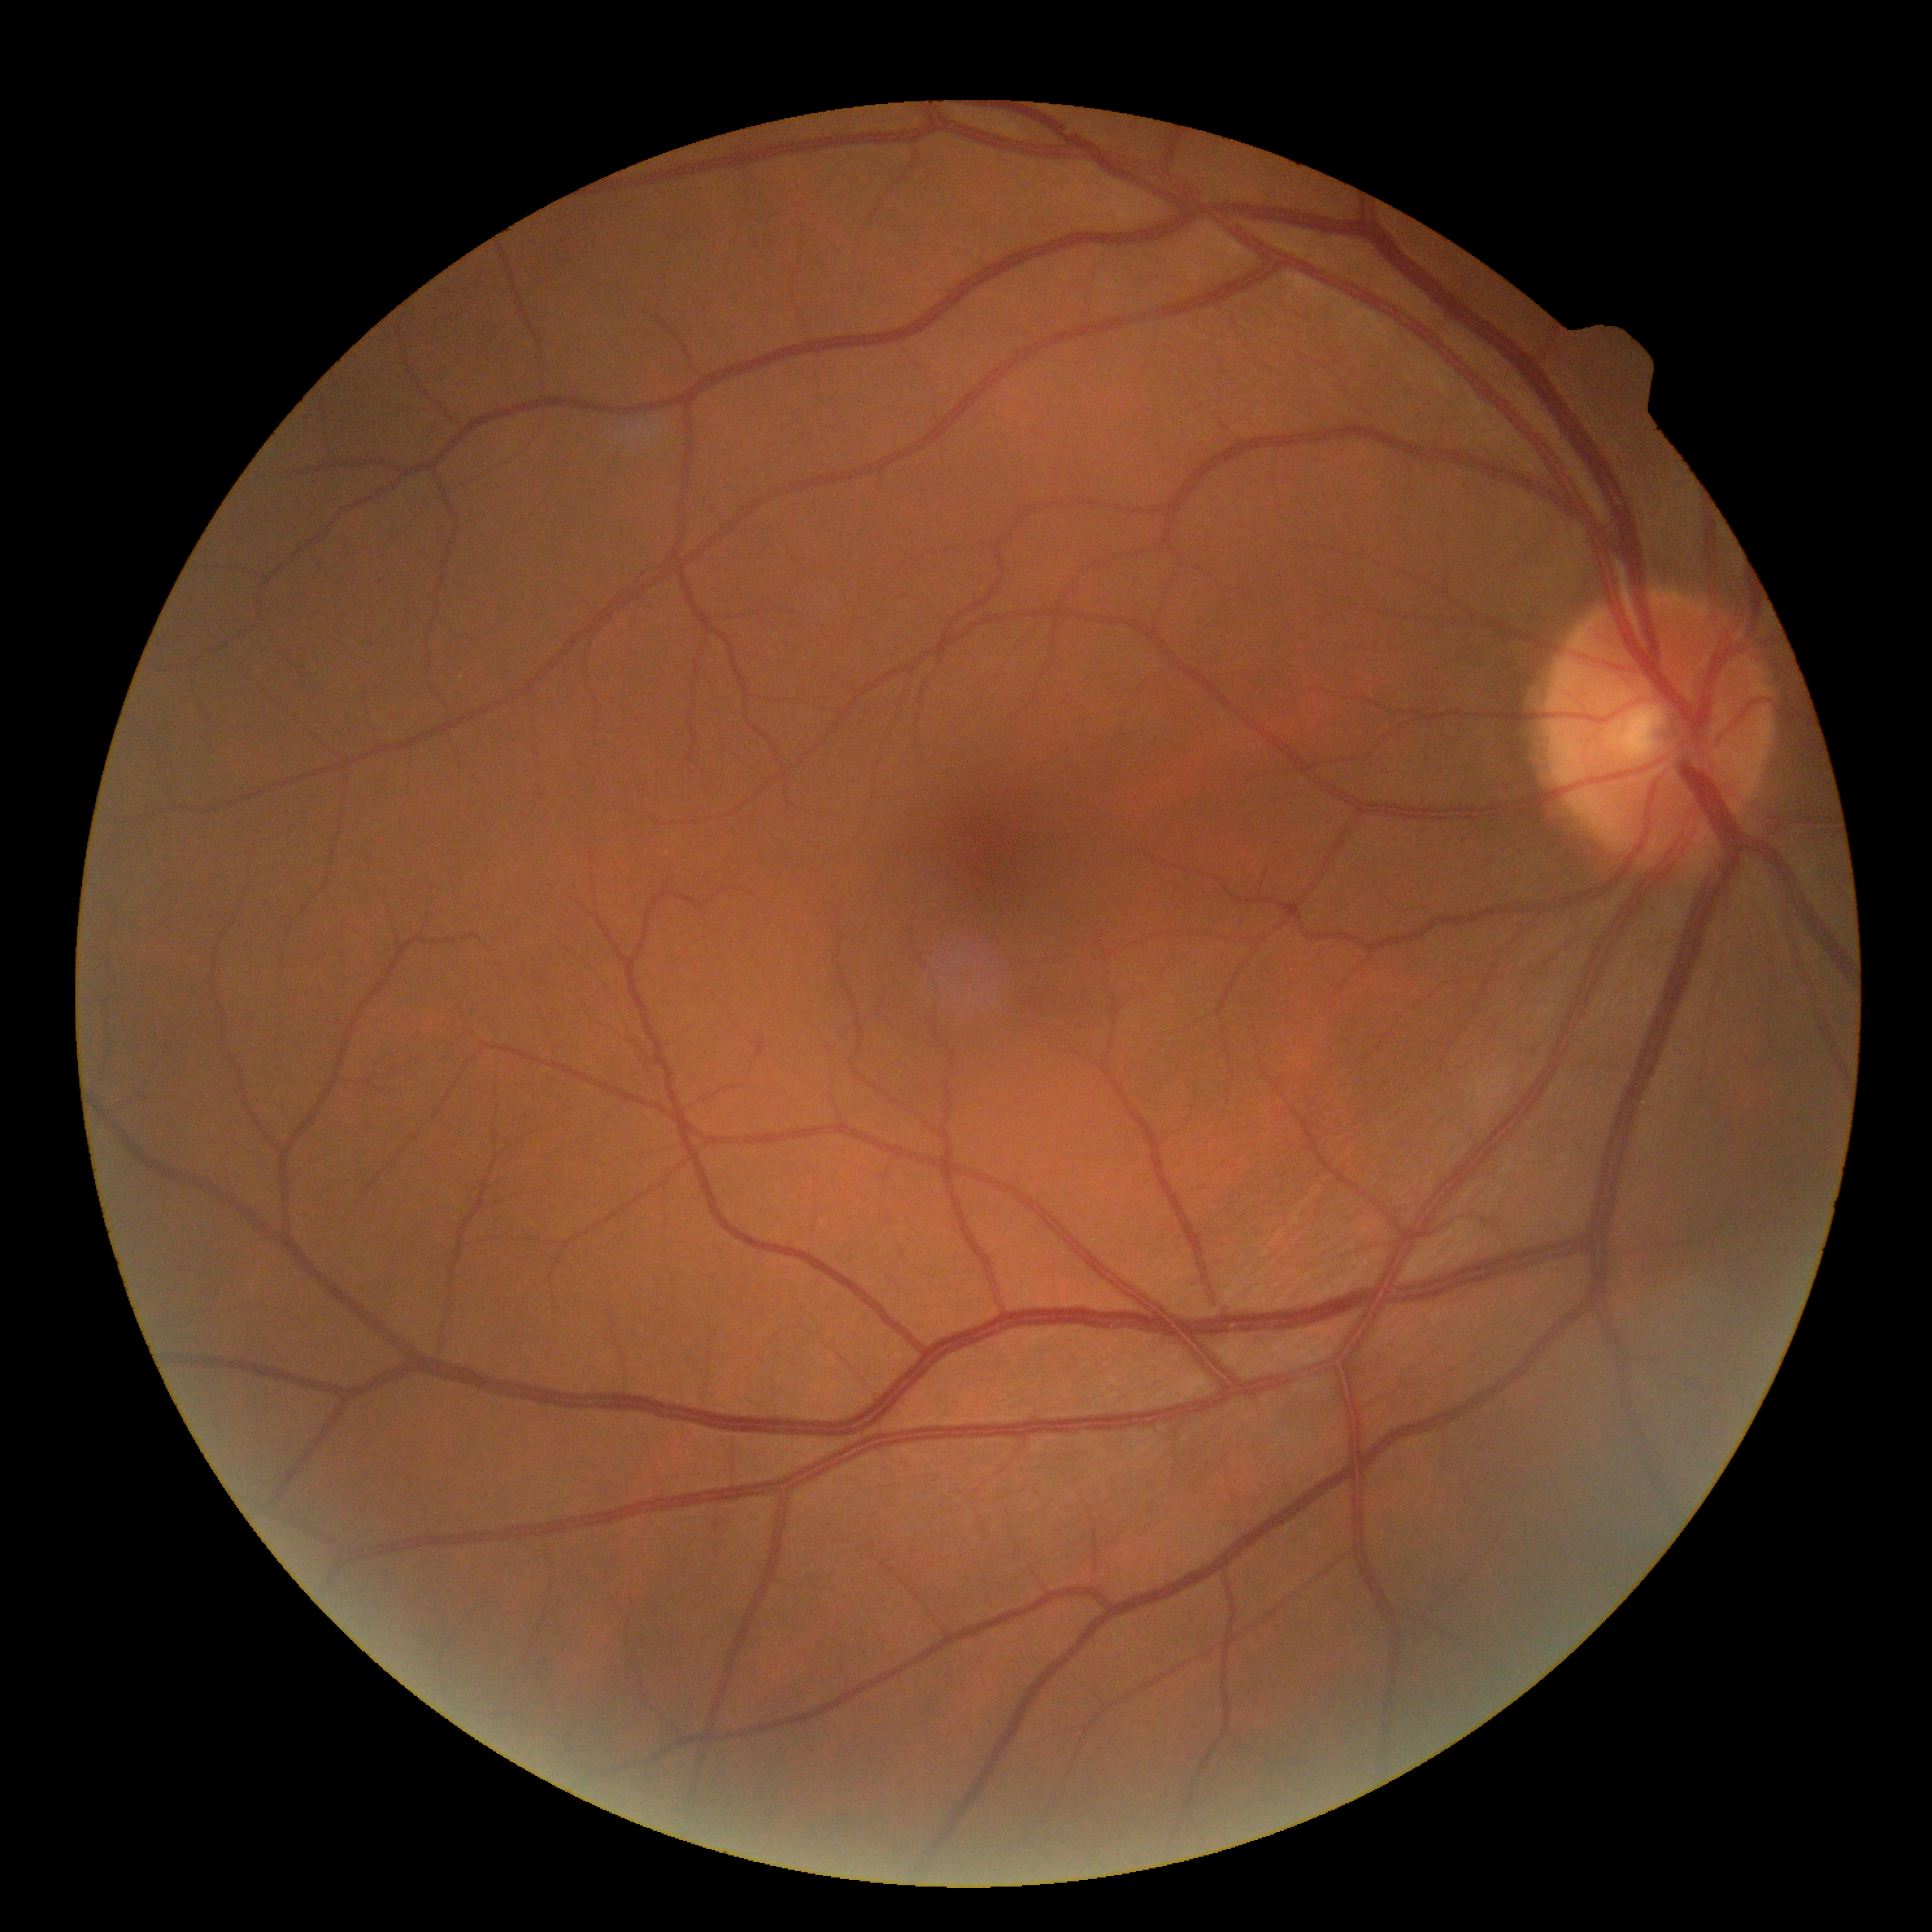
{"dr_grade": "grade 0 (no apparent retinopathy)", "dr_impression": "no apparent DR"}